Color fundus image, 45° field of view, 2212 x 1659 pixels.
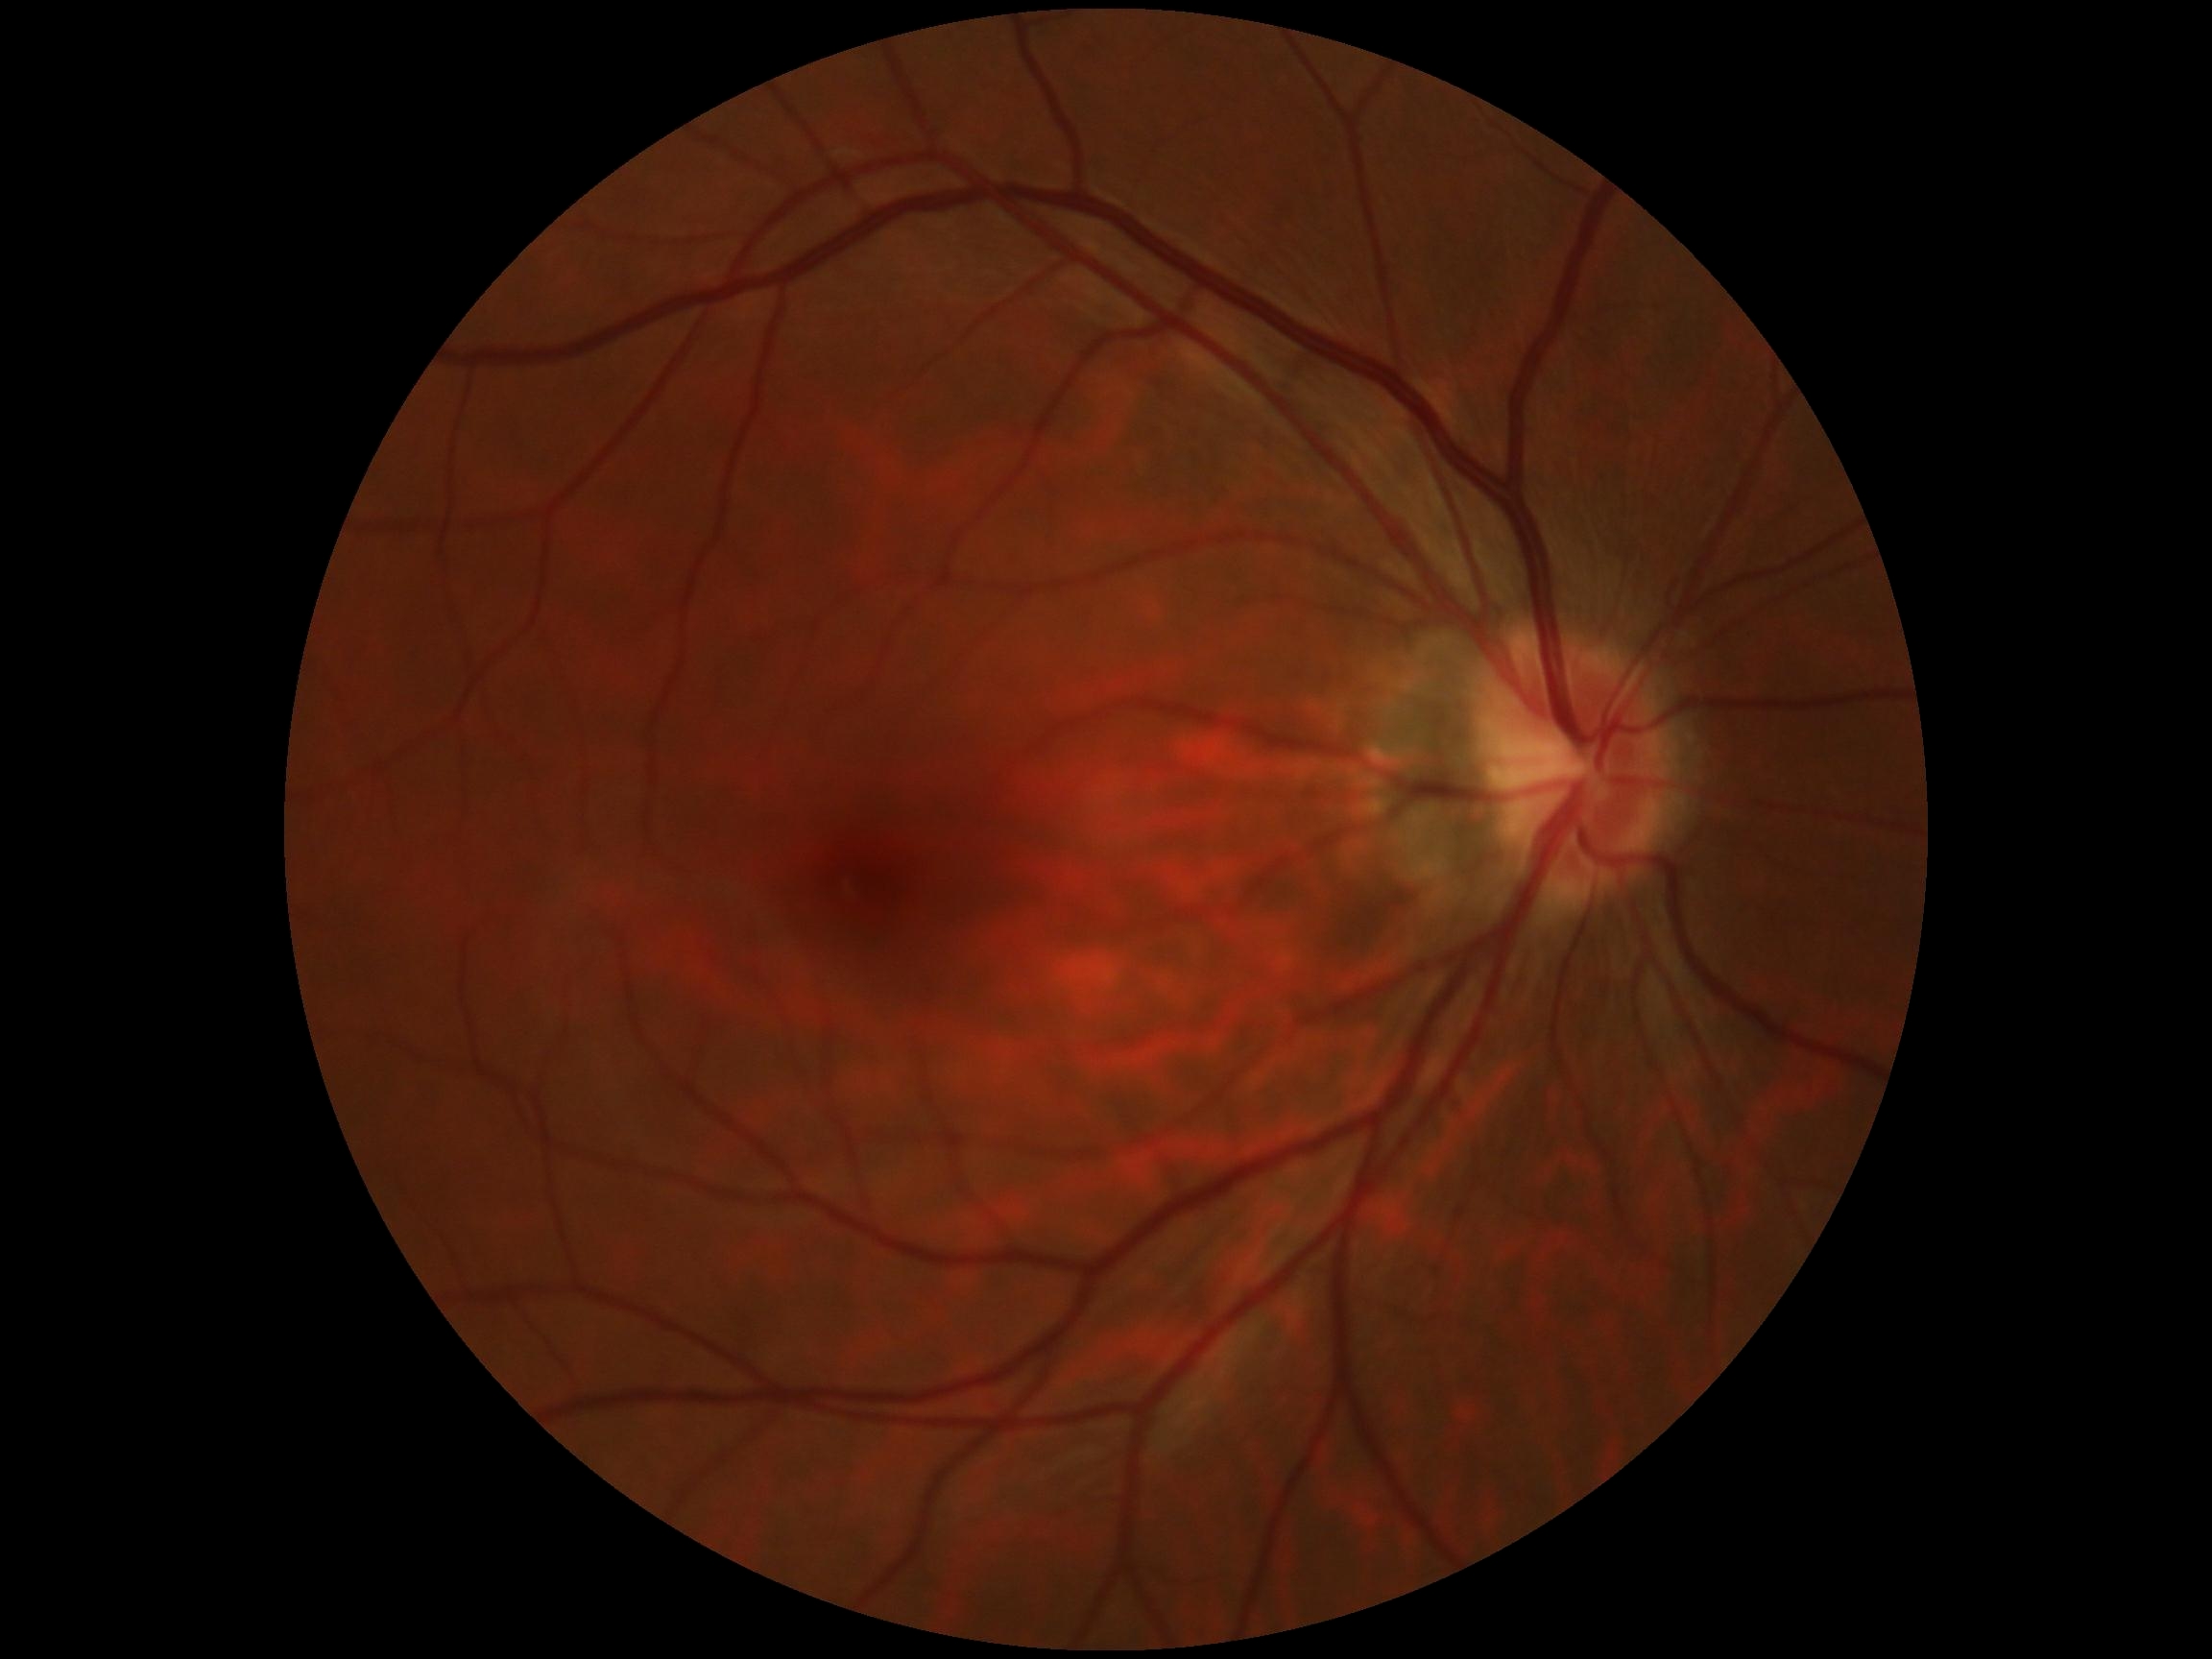

diabetic retinopathy@grade 0 (no apparent retinopathy); DR impression@negative for DR.